Ultra-widefield (UWF) fundus image — 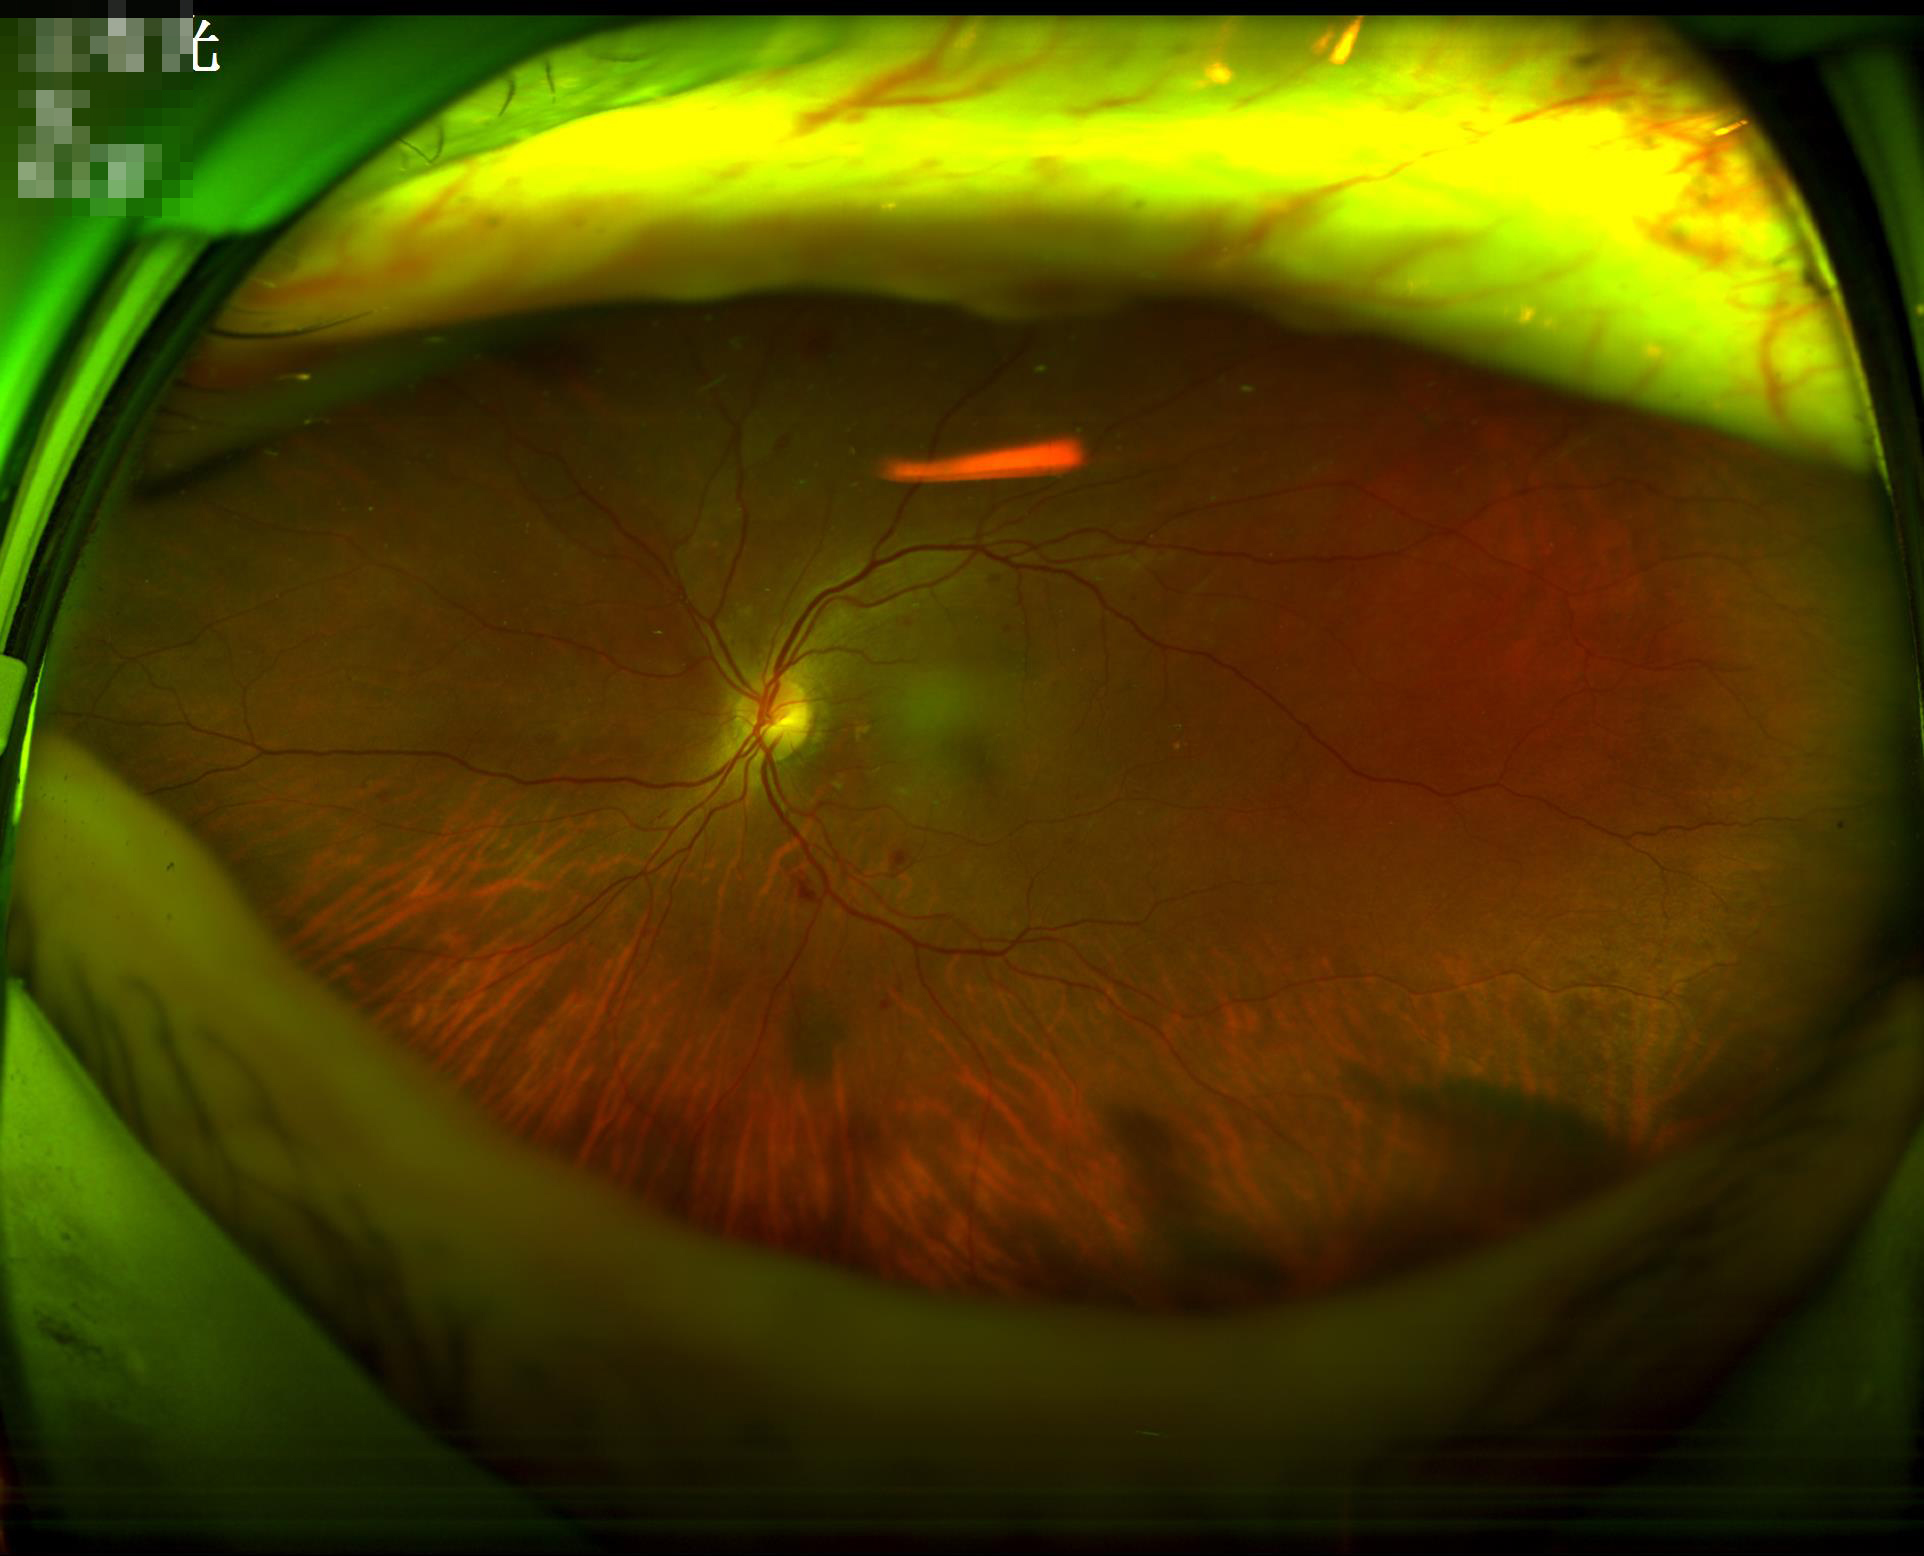

Vessels and details are readily distinguishable. Image quality is adequate for diagnostic use. Illumination and color are suboptimal. No noticeable blur.